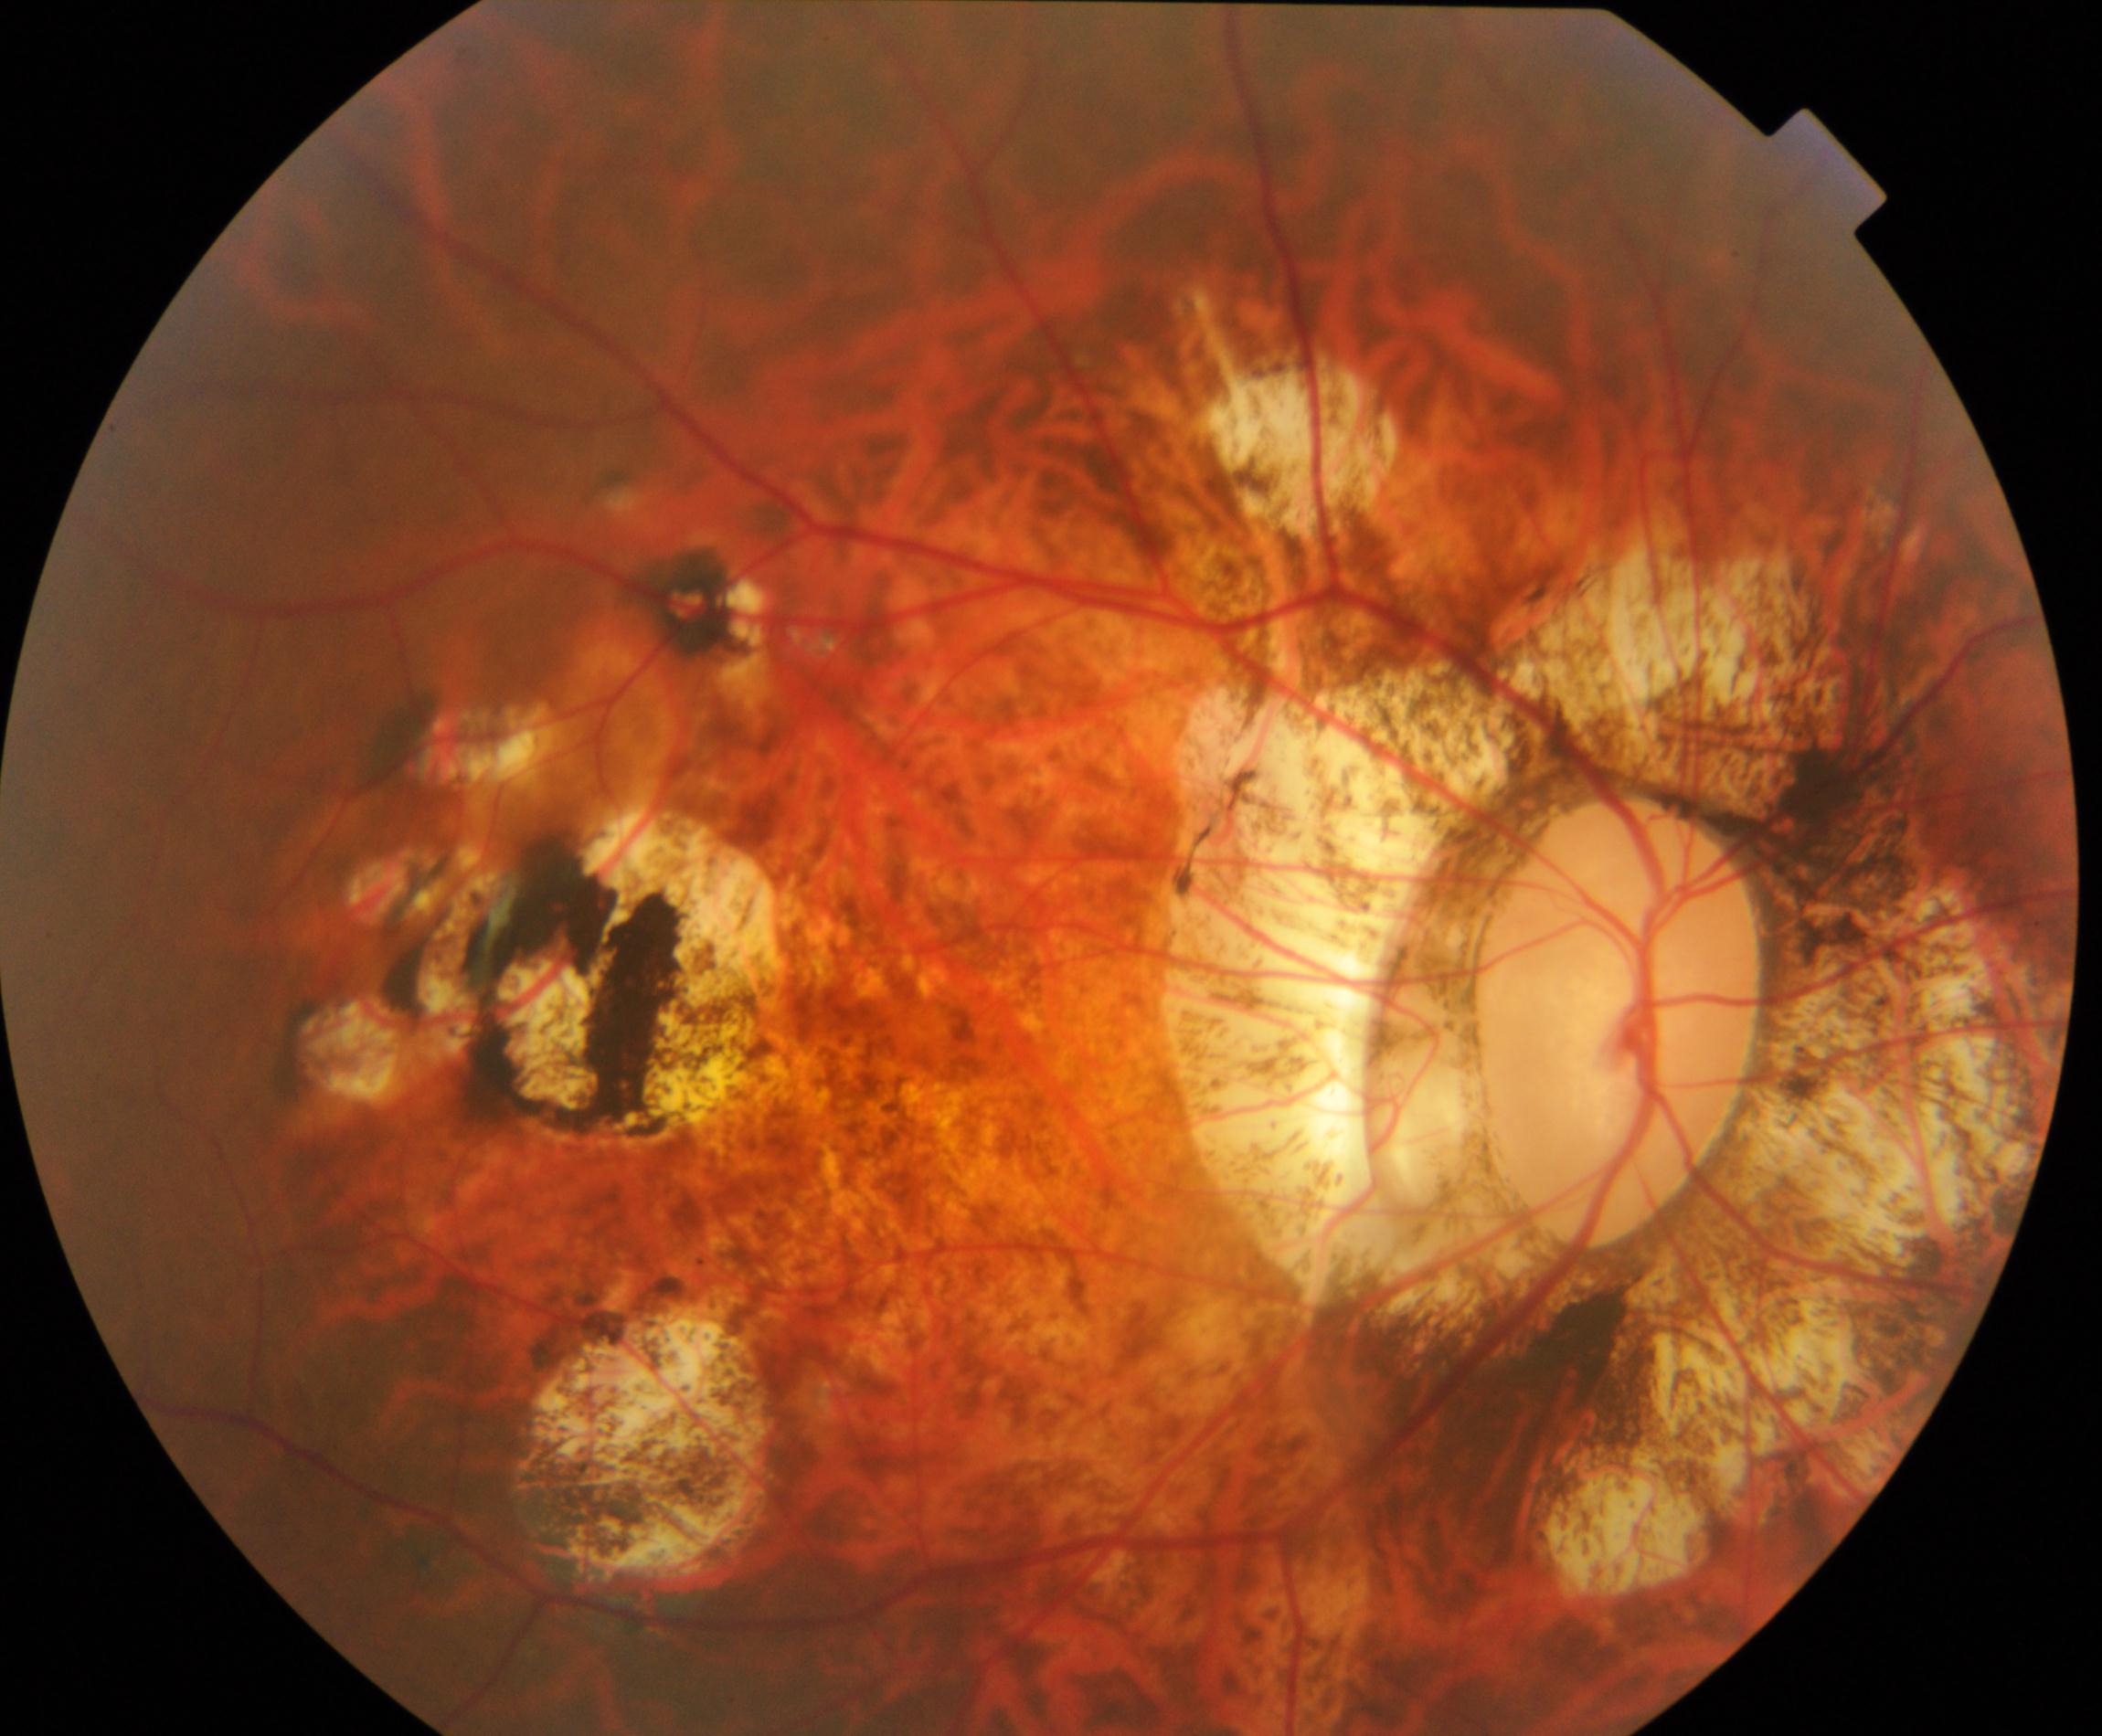

Demonstrates pathological myopia. Features include tessellated fundus with focal chorioretinal atrophy, Fuchs spot, lacquer cracks, choroidal neovascularization, or subretinal hemorrhage.